45 degree fundus photograph
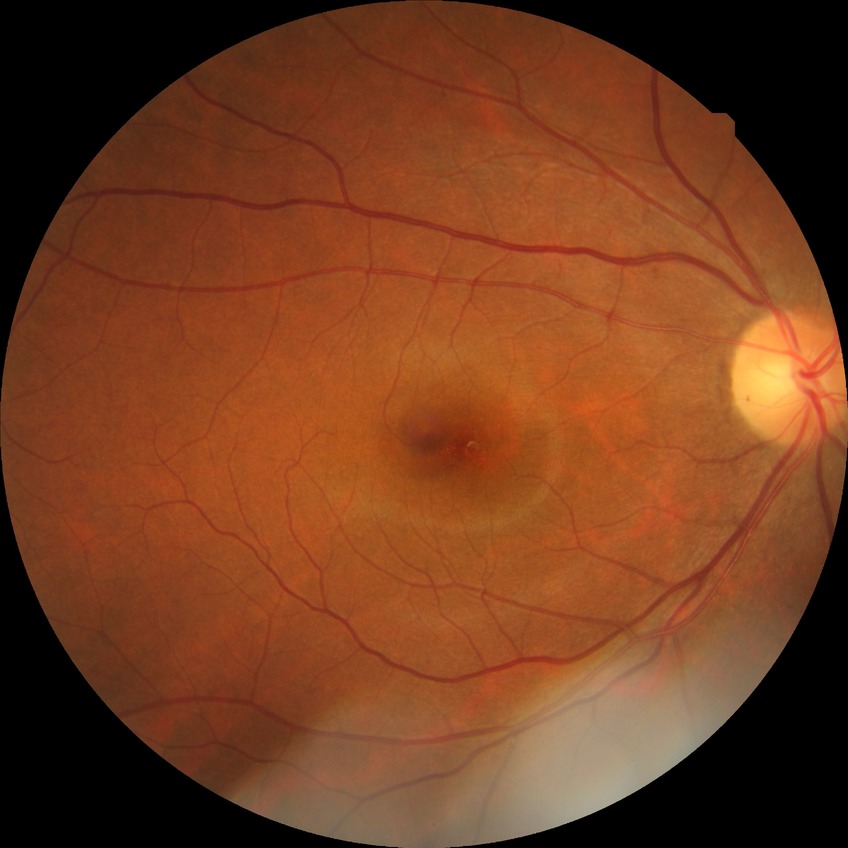

Modified Davis grade: NDR. No signs of diabetic retinopathy.